Pediatric retinal photograph (wide-field). Acquired on the Clarity RetCam 3: 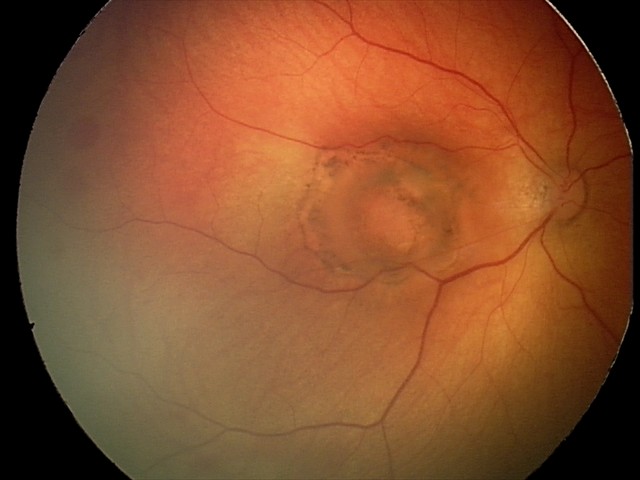

Screening diagnosis: toxoplasmosis chorioretinitis.